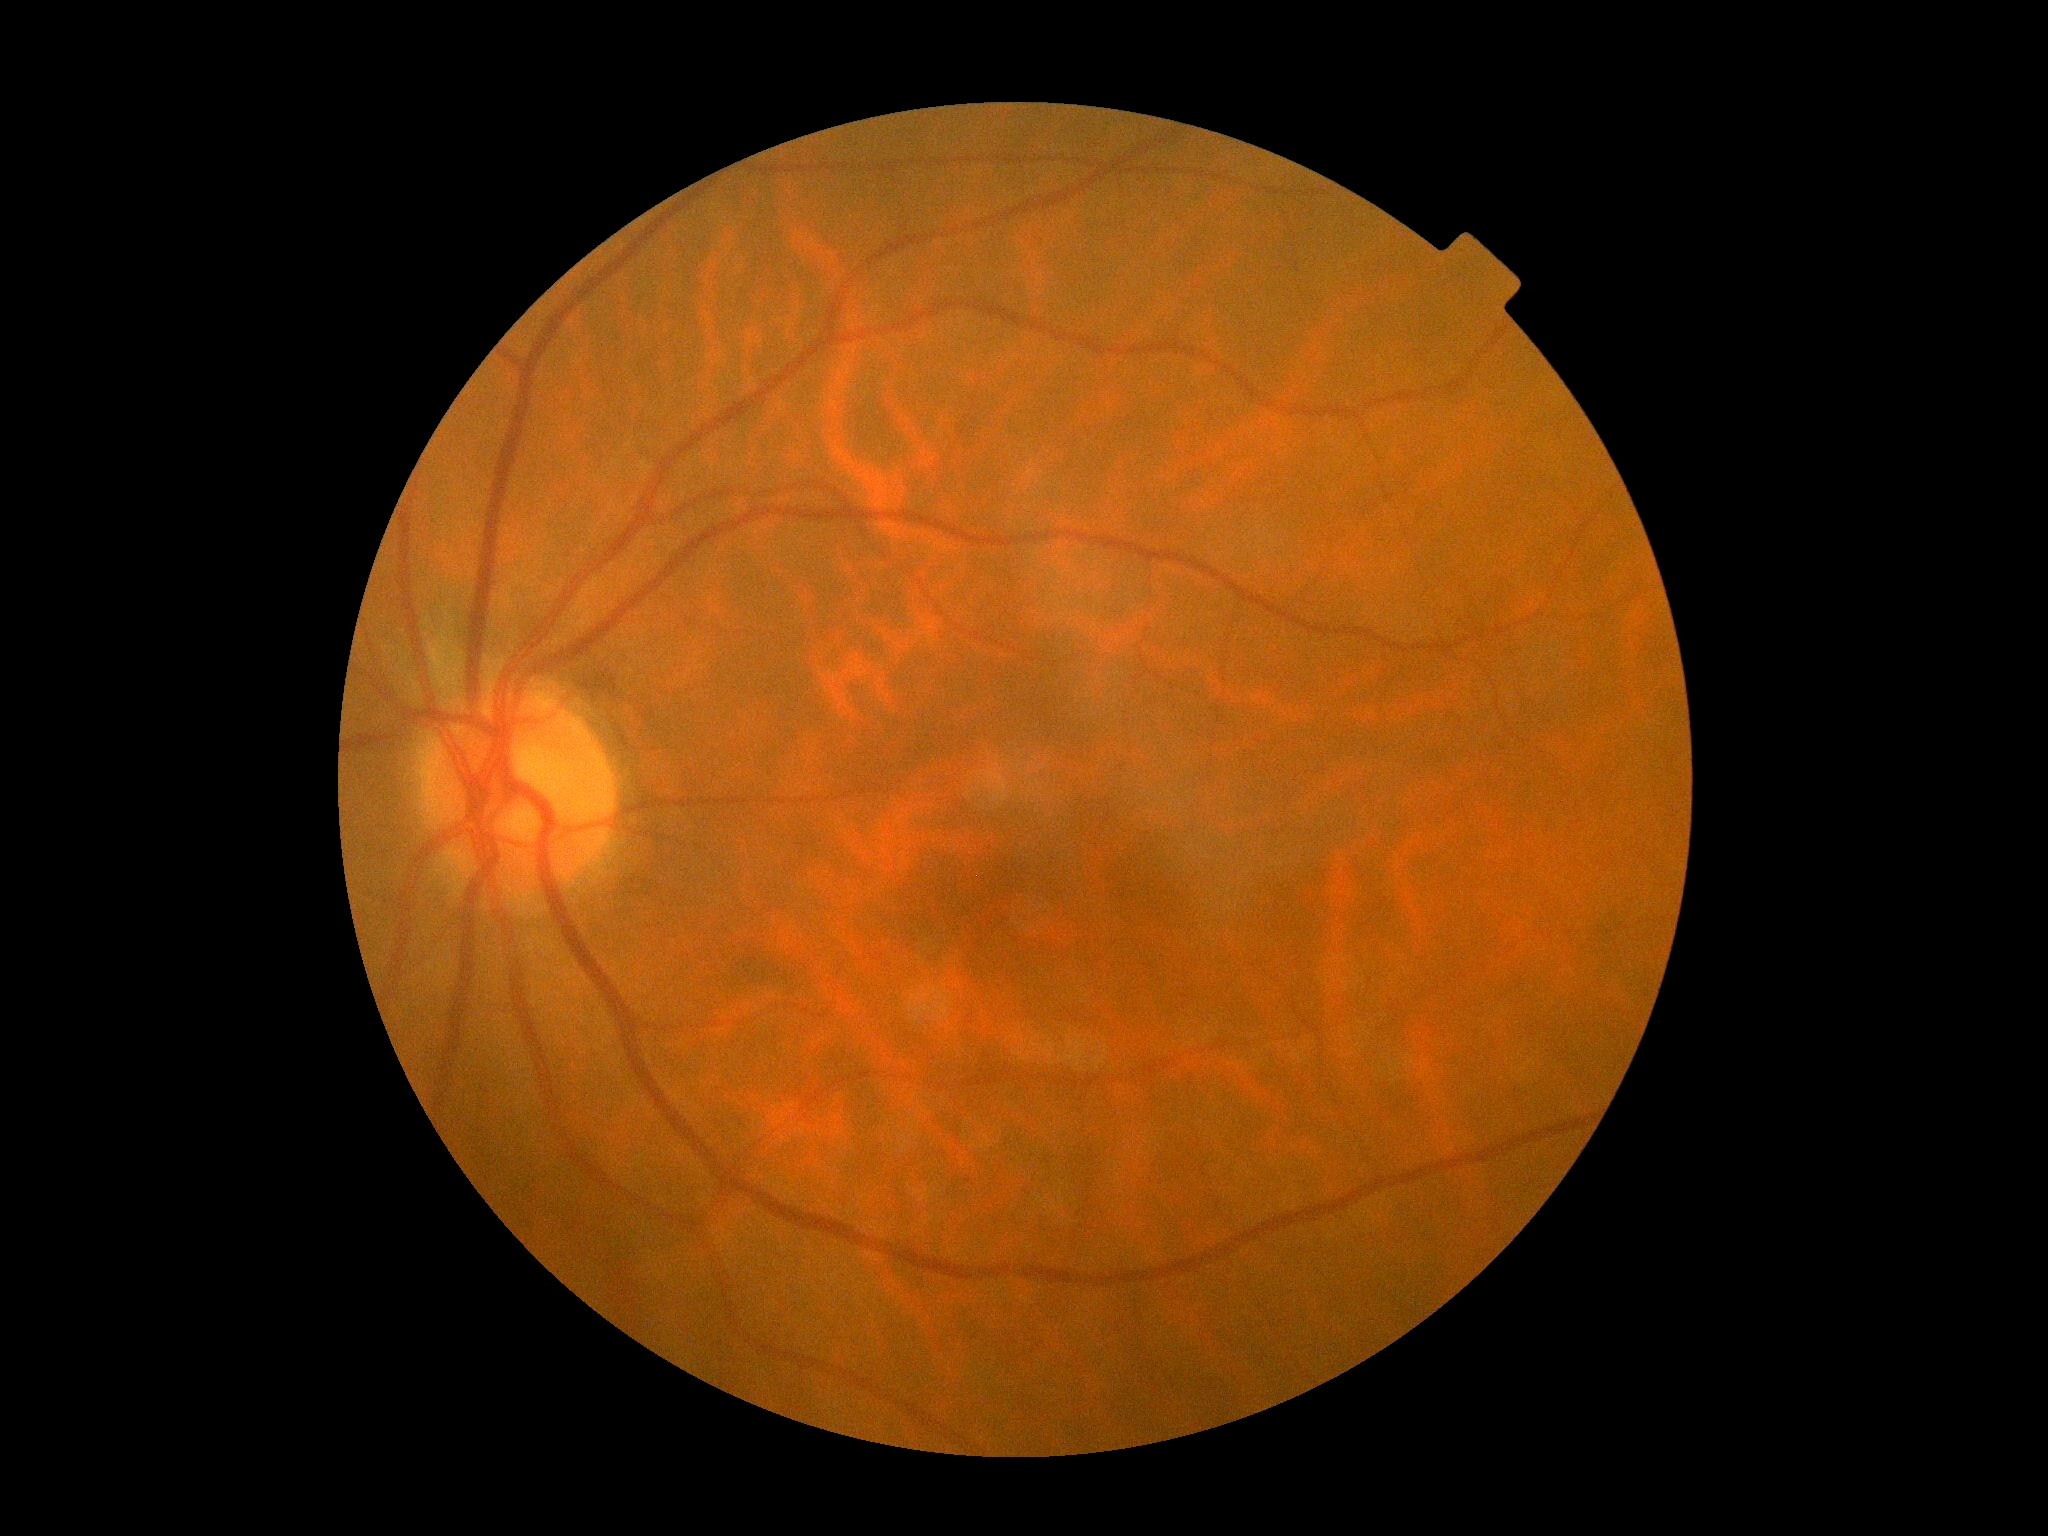 Diabetic retinopathy severity is grade 0 (no apparent retinopathy).